Davis DR grading — 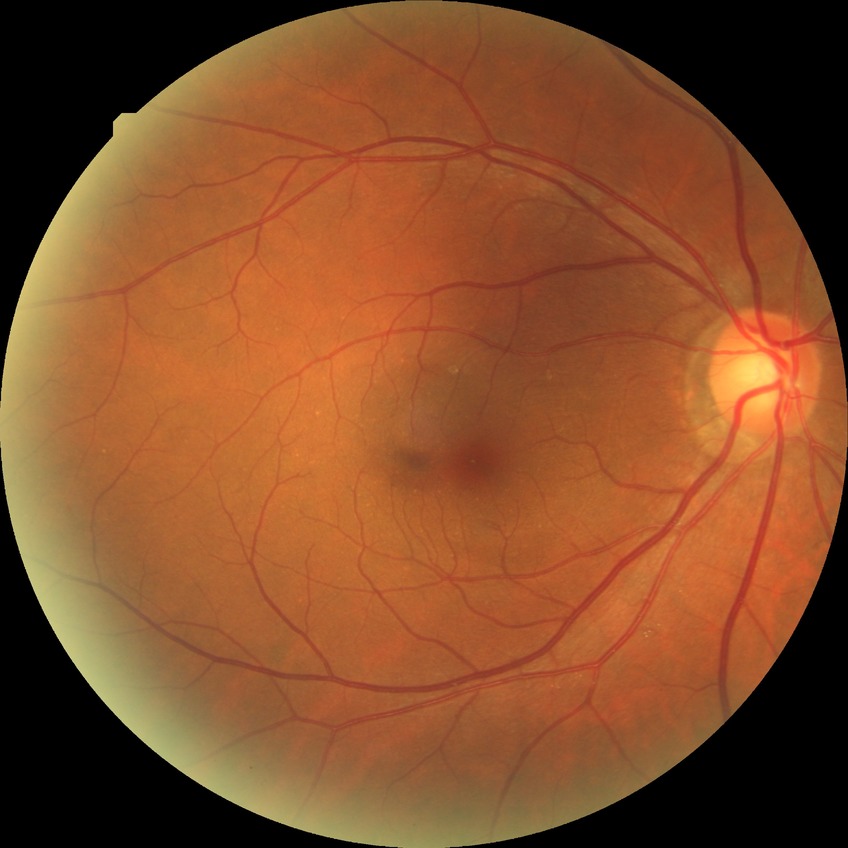 Modified Davis grading is no diabetic retinopathy.